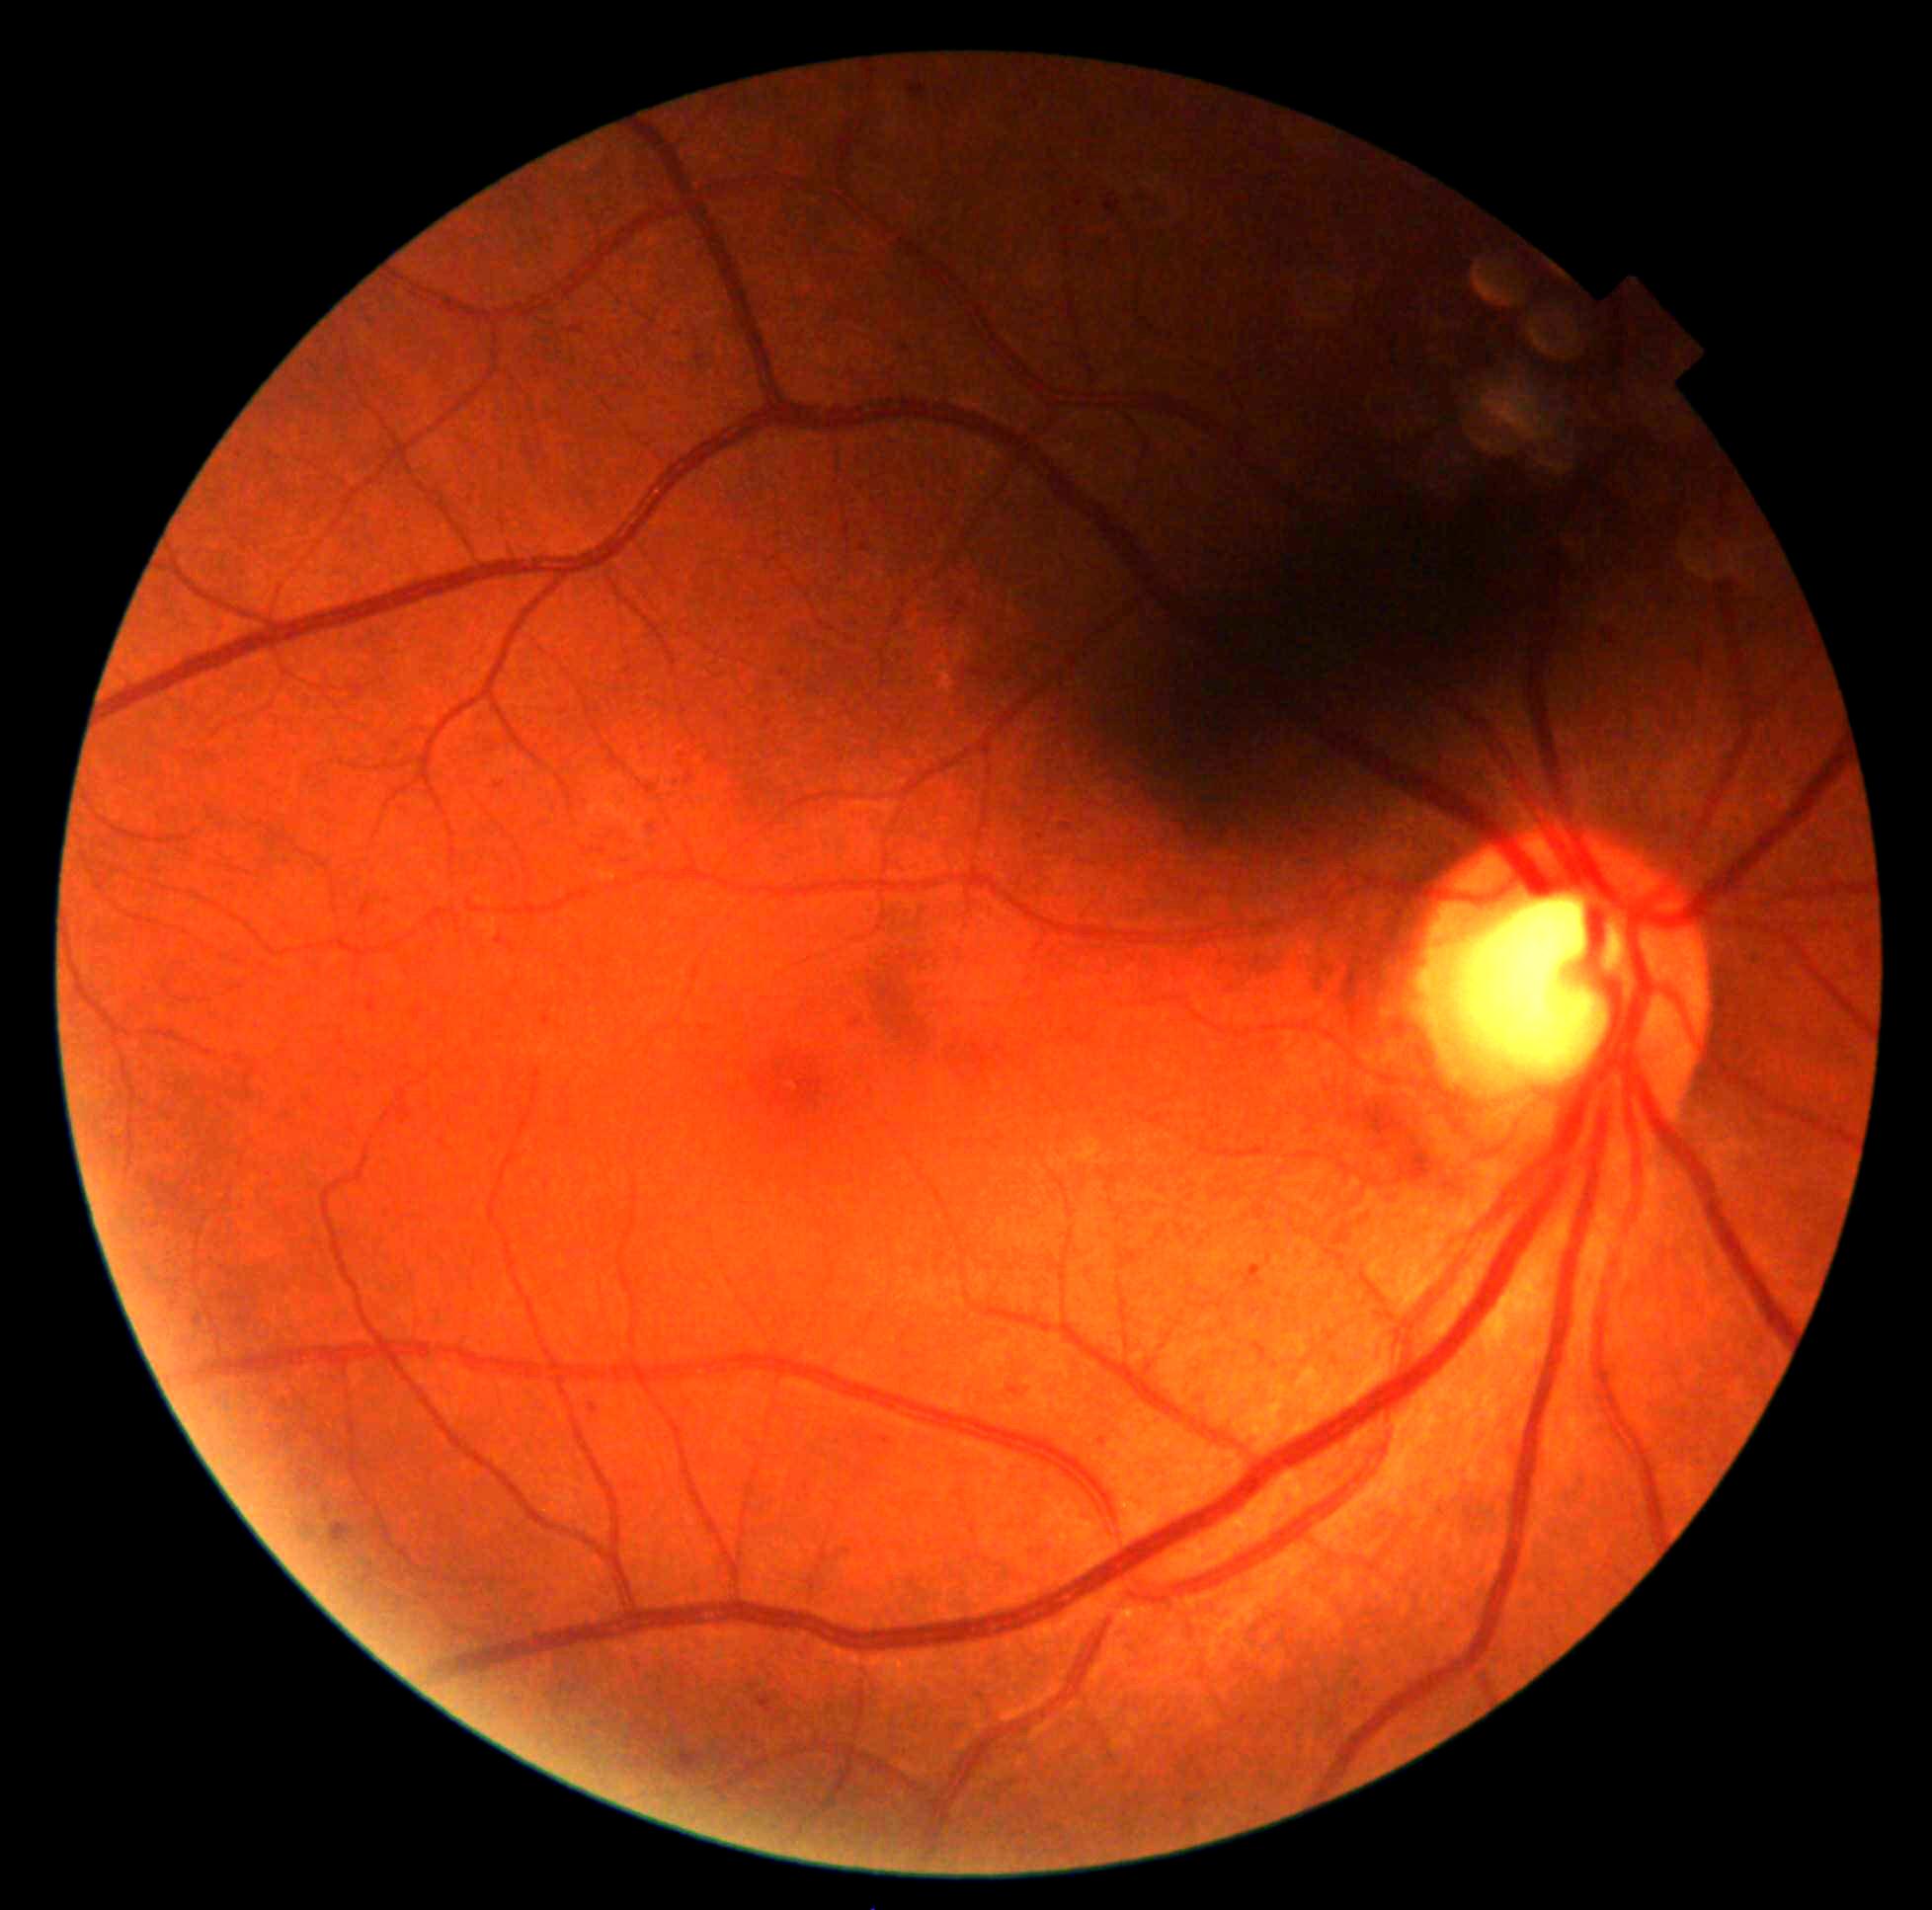
Diabetic retinopathy severity: grade 1.